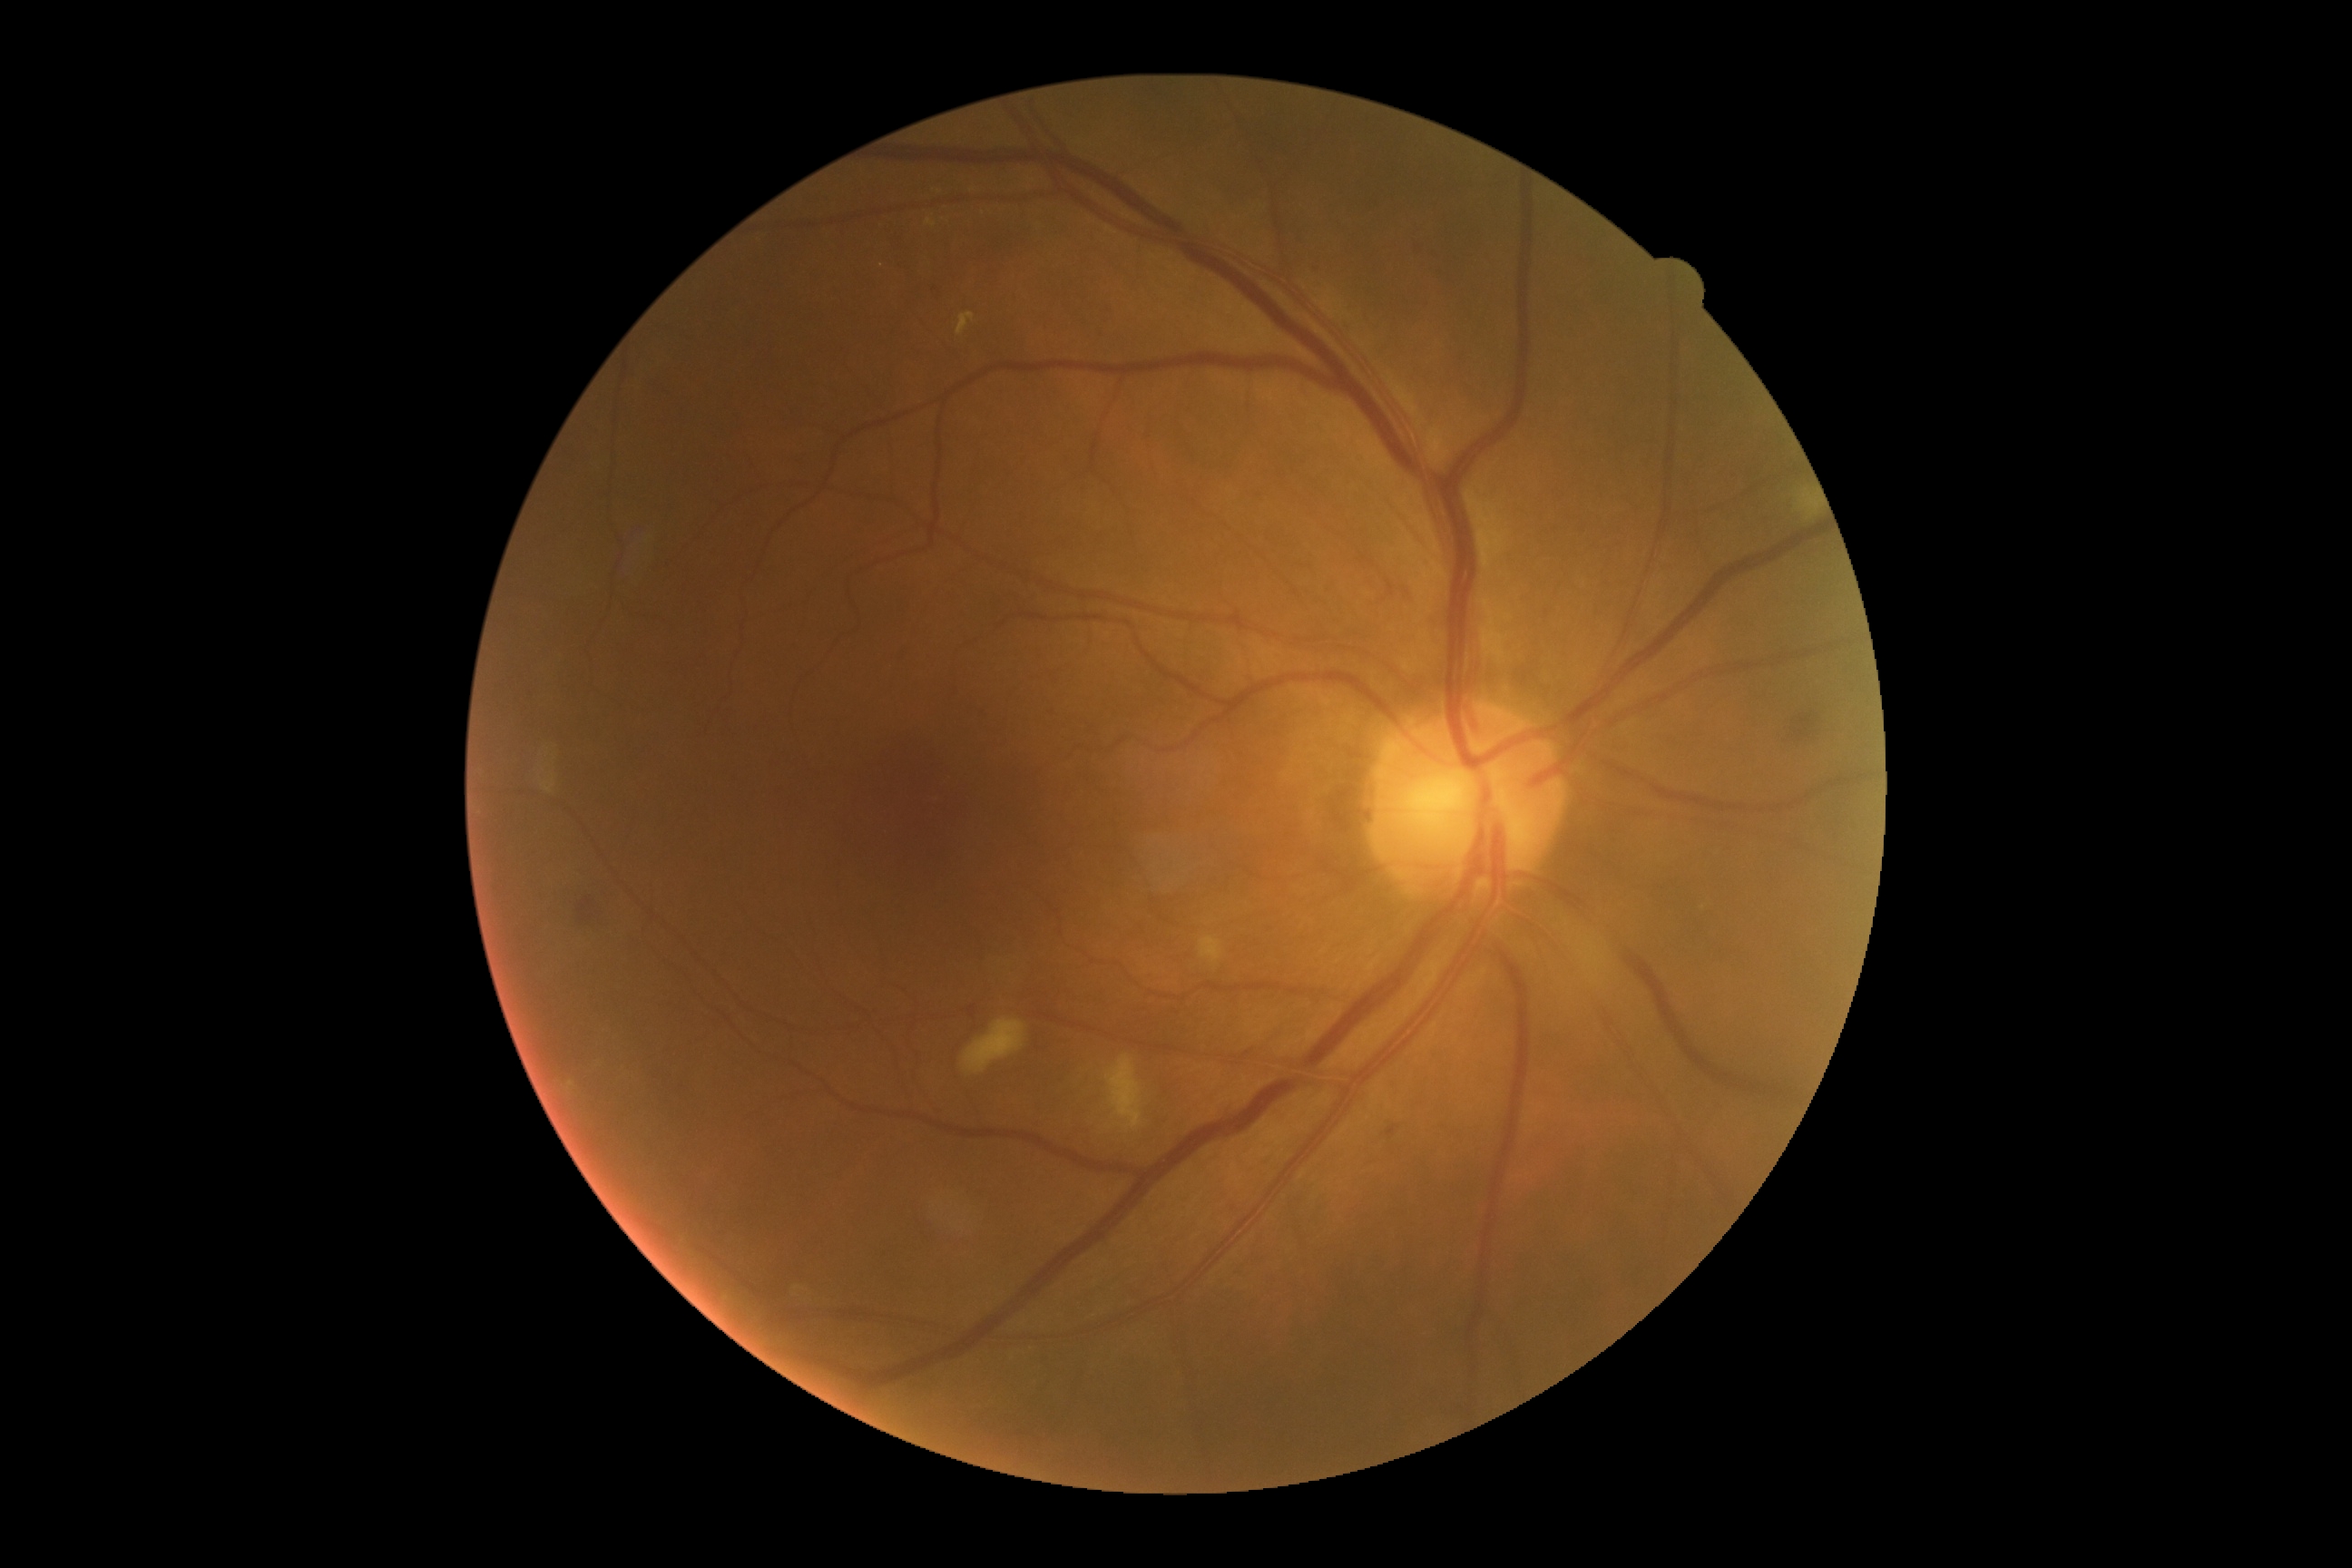
Diabetic retinopathy severity is grade 2 (moderate NPDR).